2352x1568px.
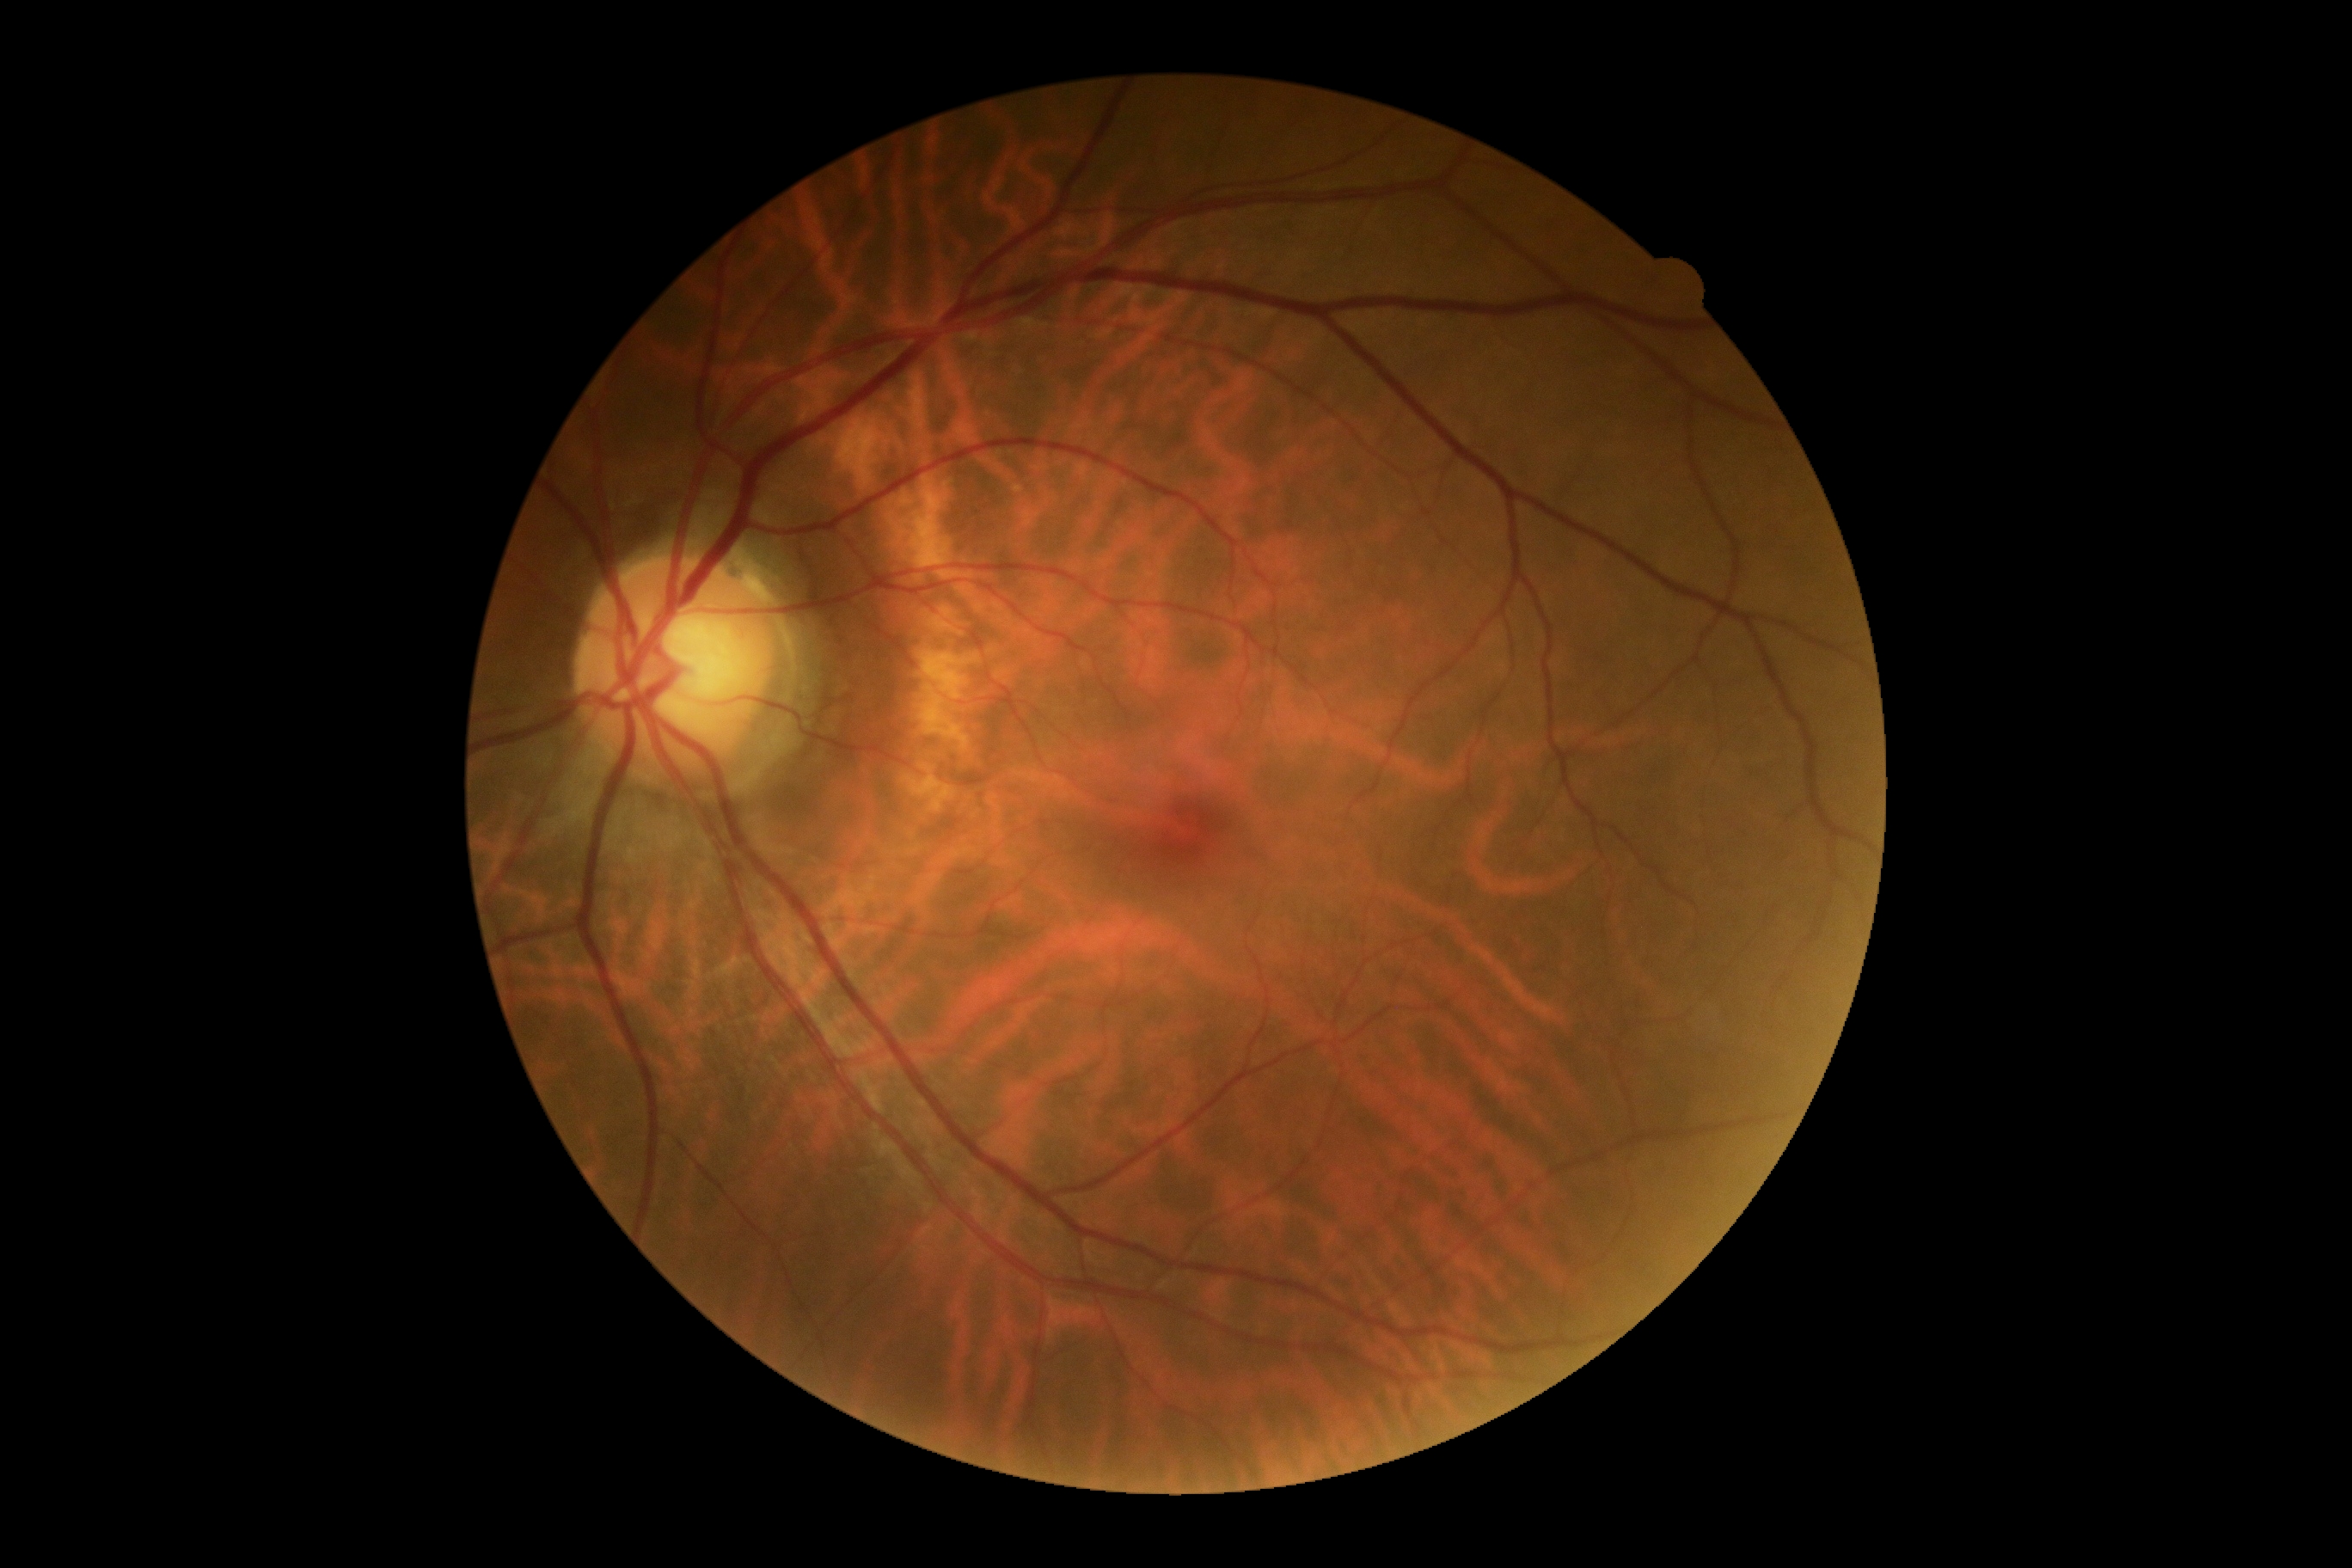

{"dr_impression": "negative for DR", "dr_grade": "0"}